Acquired with a NIDEK AFC-230. No pharmacologic dilation:
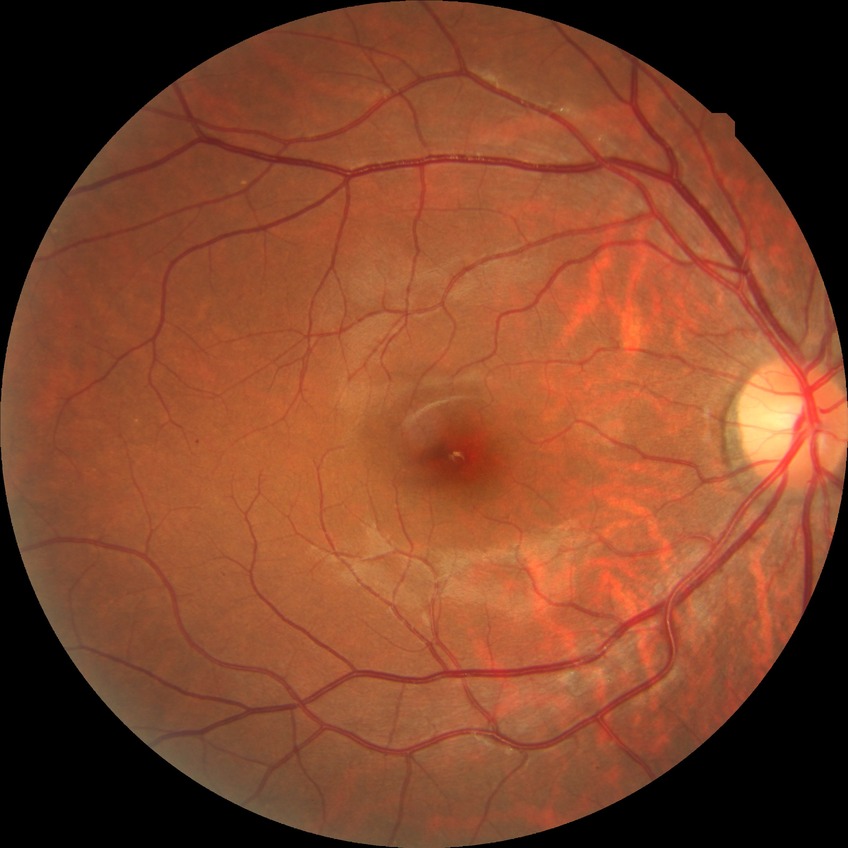 Modified Davis classification is simple diabetic retinopathy.